Wide-field contact fundus photograph of an infant; captured with the Phoenix ICON (100° field of view); 1240x1240px — 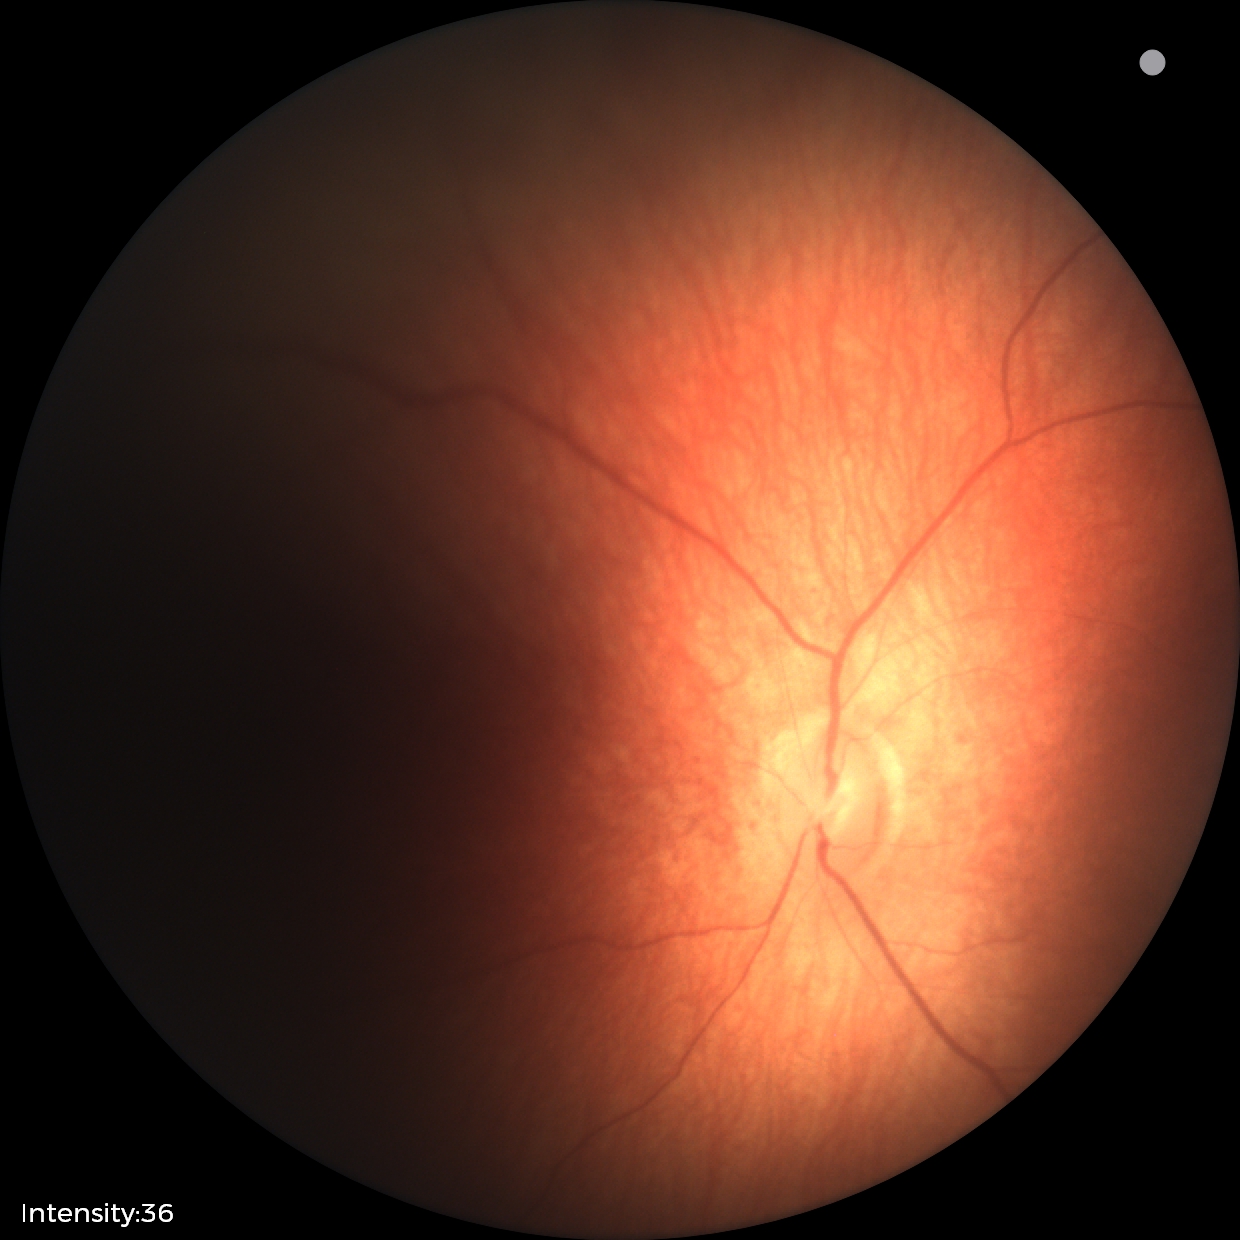

Normal screening examination.